Color fundus photograph — 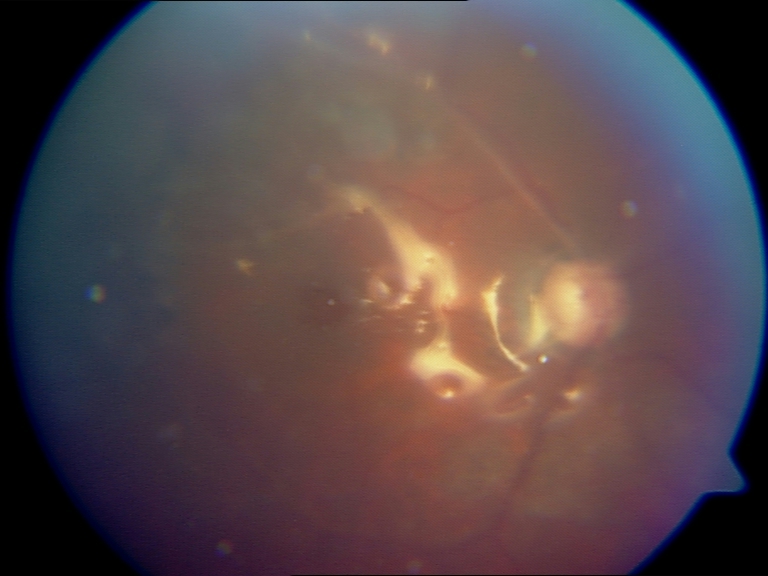 Treatment history: silicone oil in the eye.